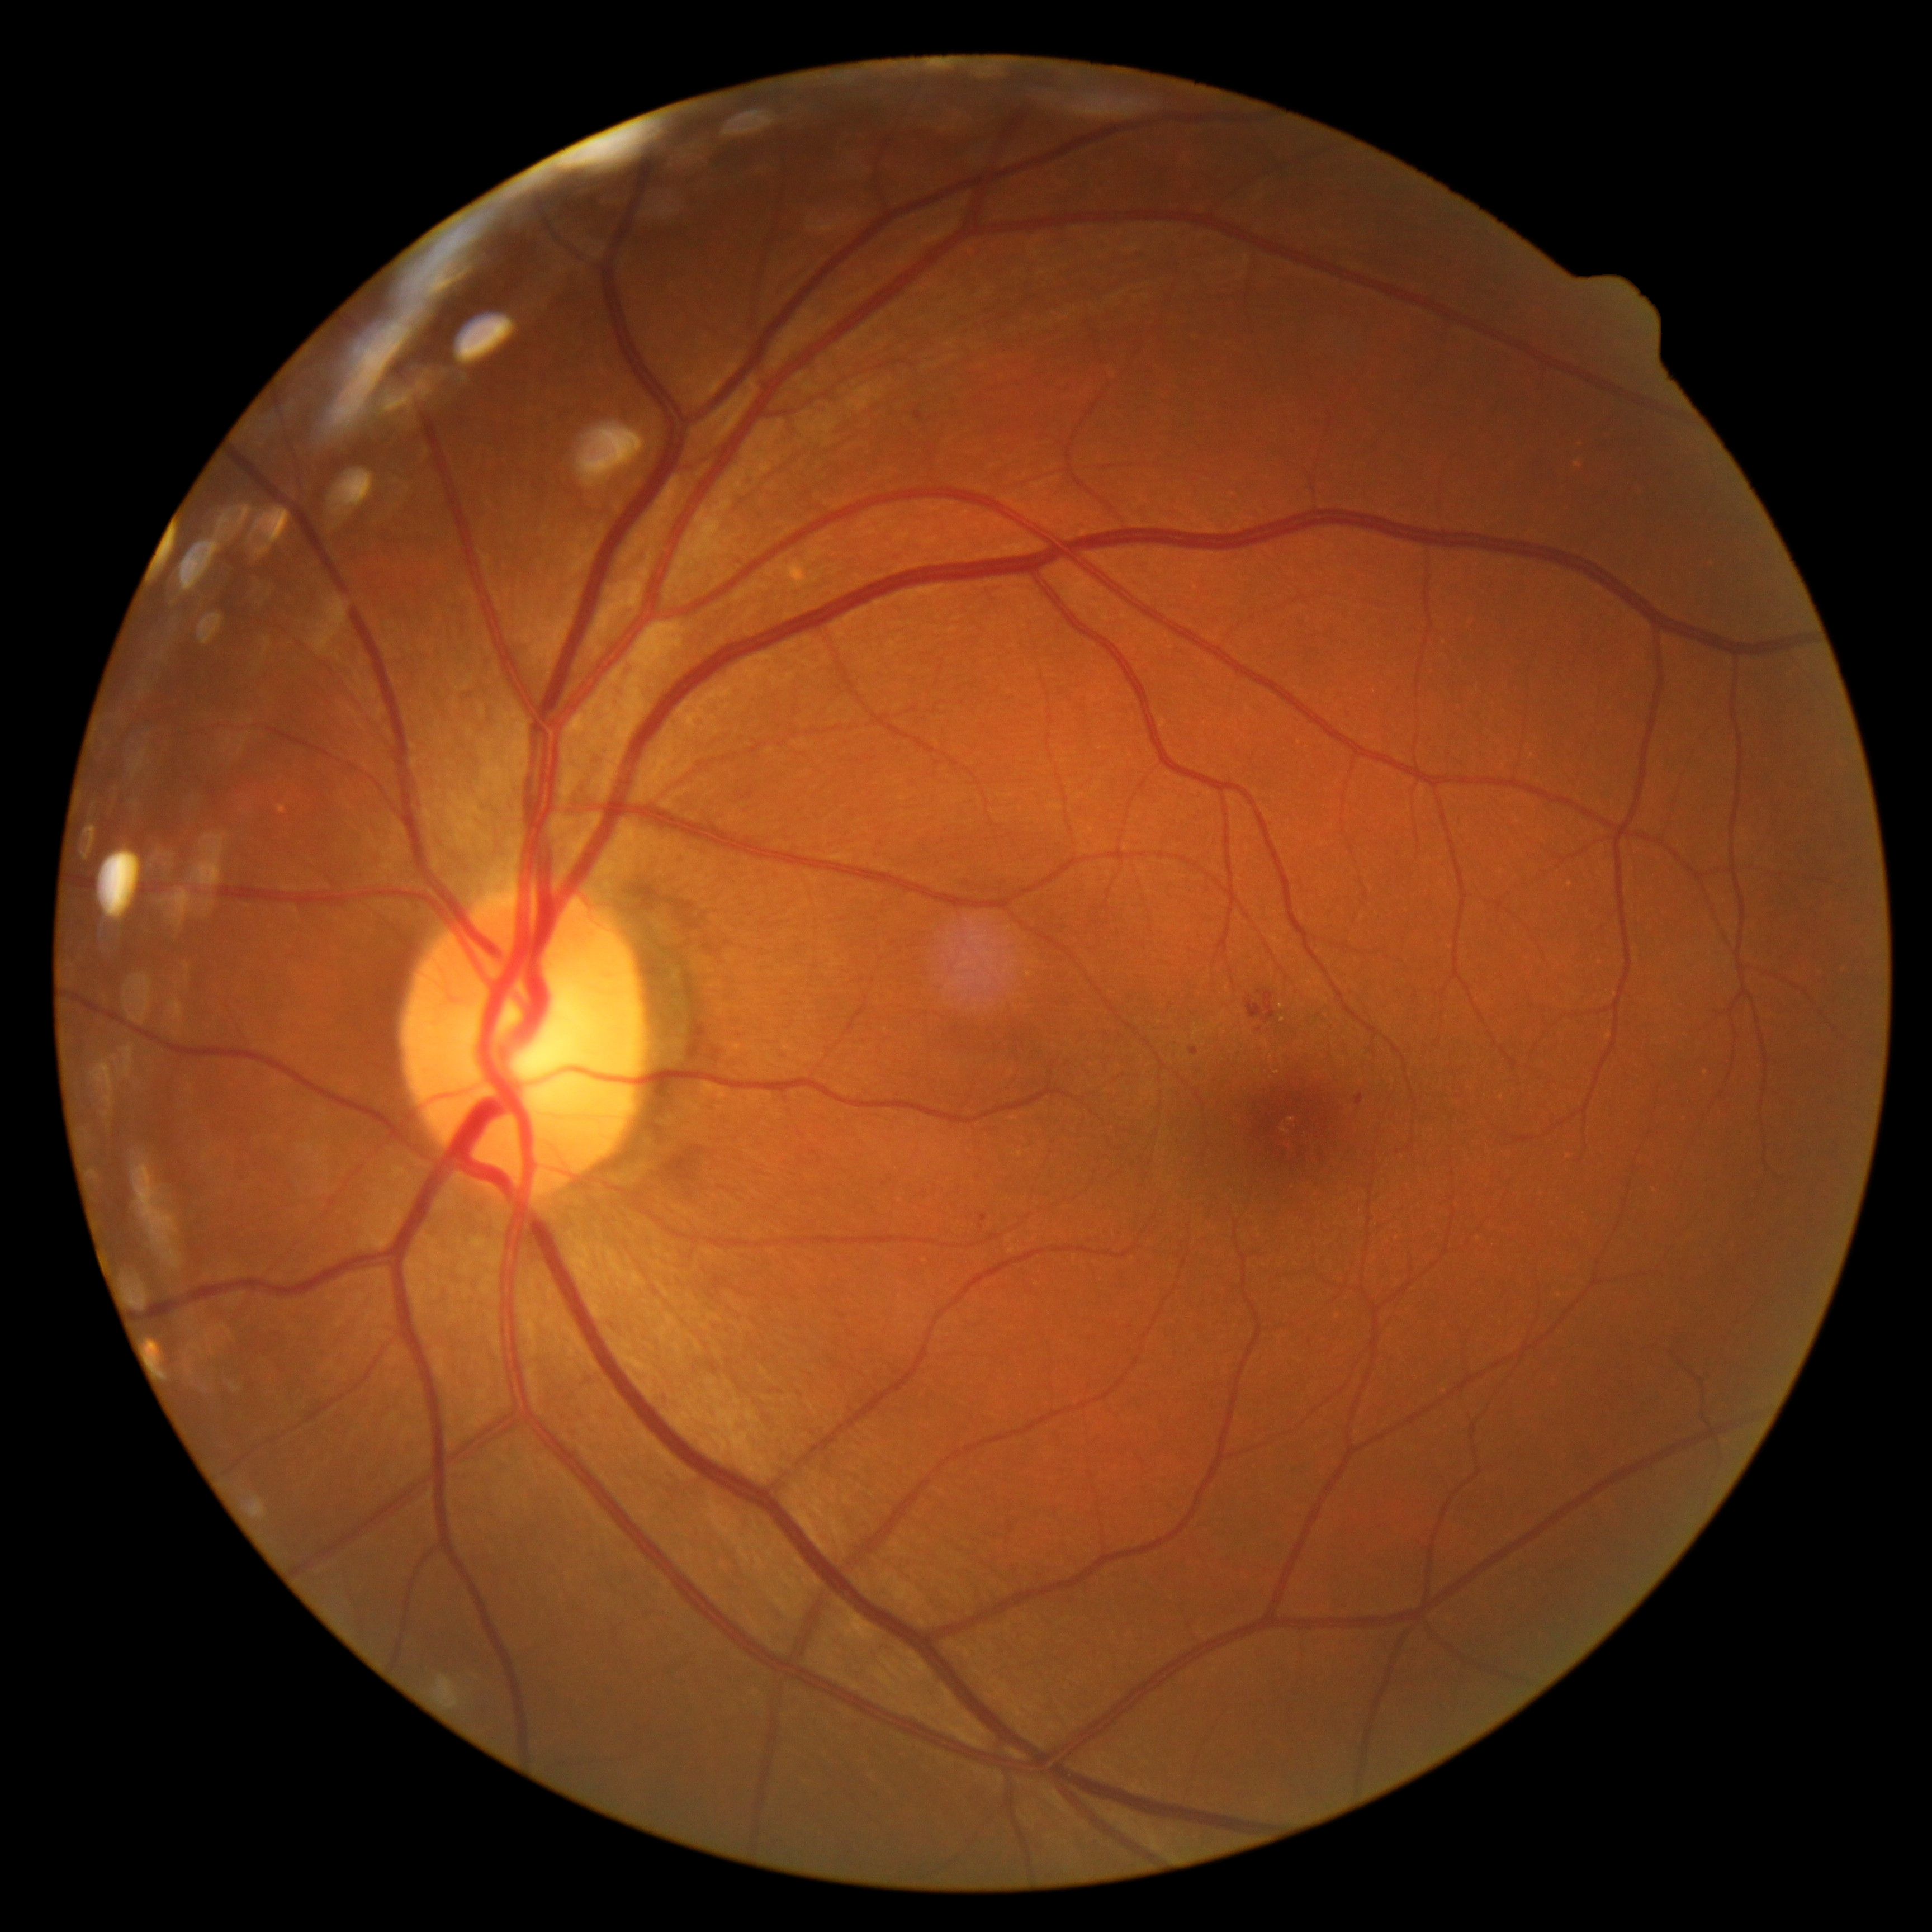 Diabetic retinopathy is moderate non-proliferative diabetic retinopathy (grade 2).